FOV: 45 degrees.
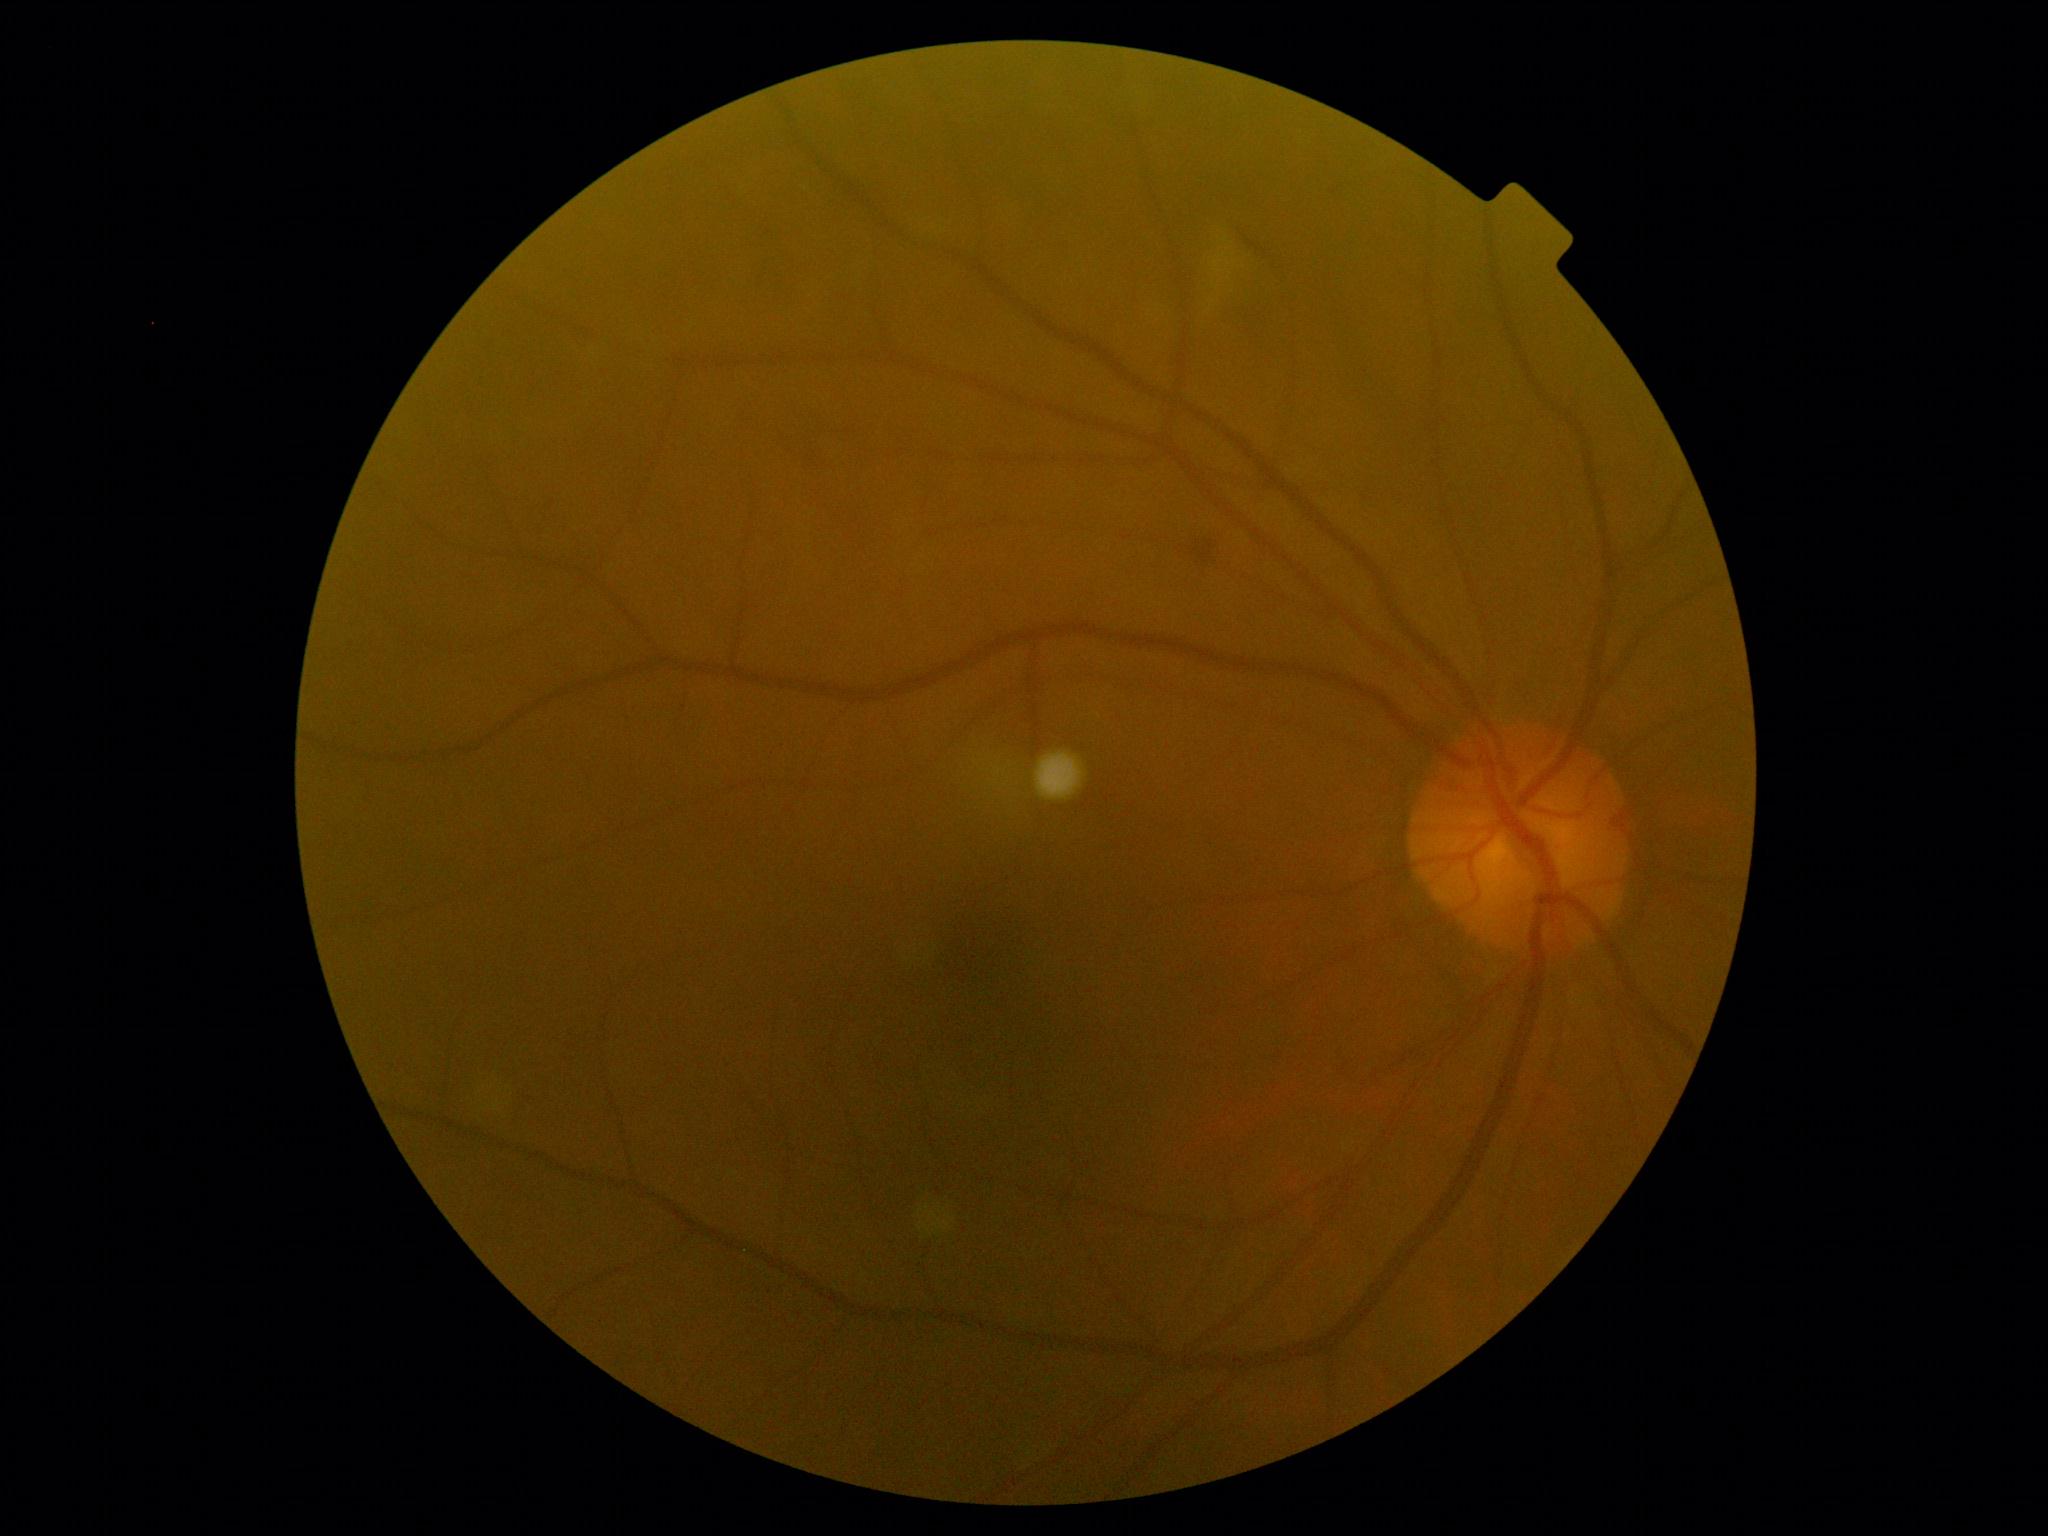 {
  "dr_grade": "grade 2 (moderate NPDR)"
}